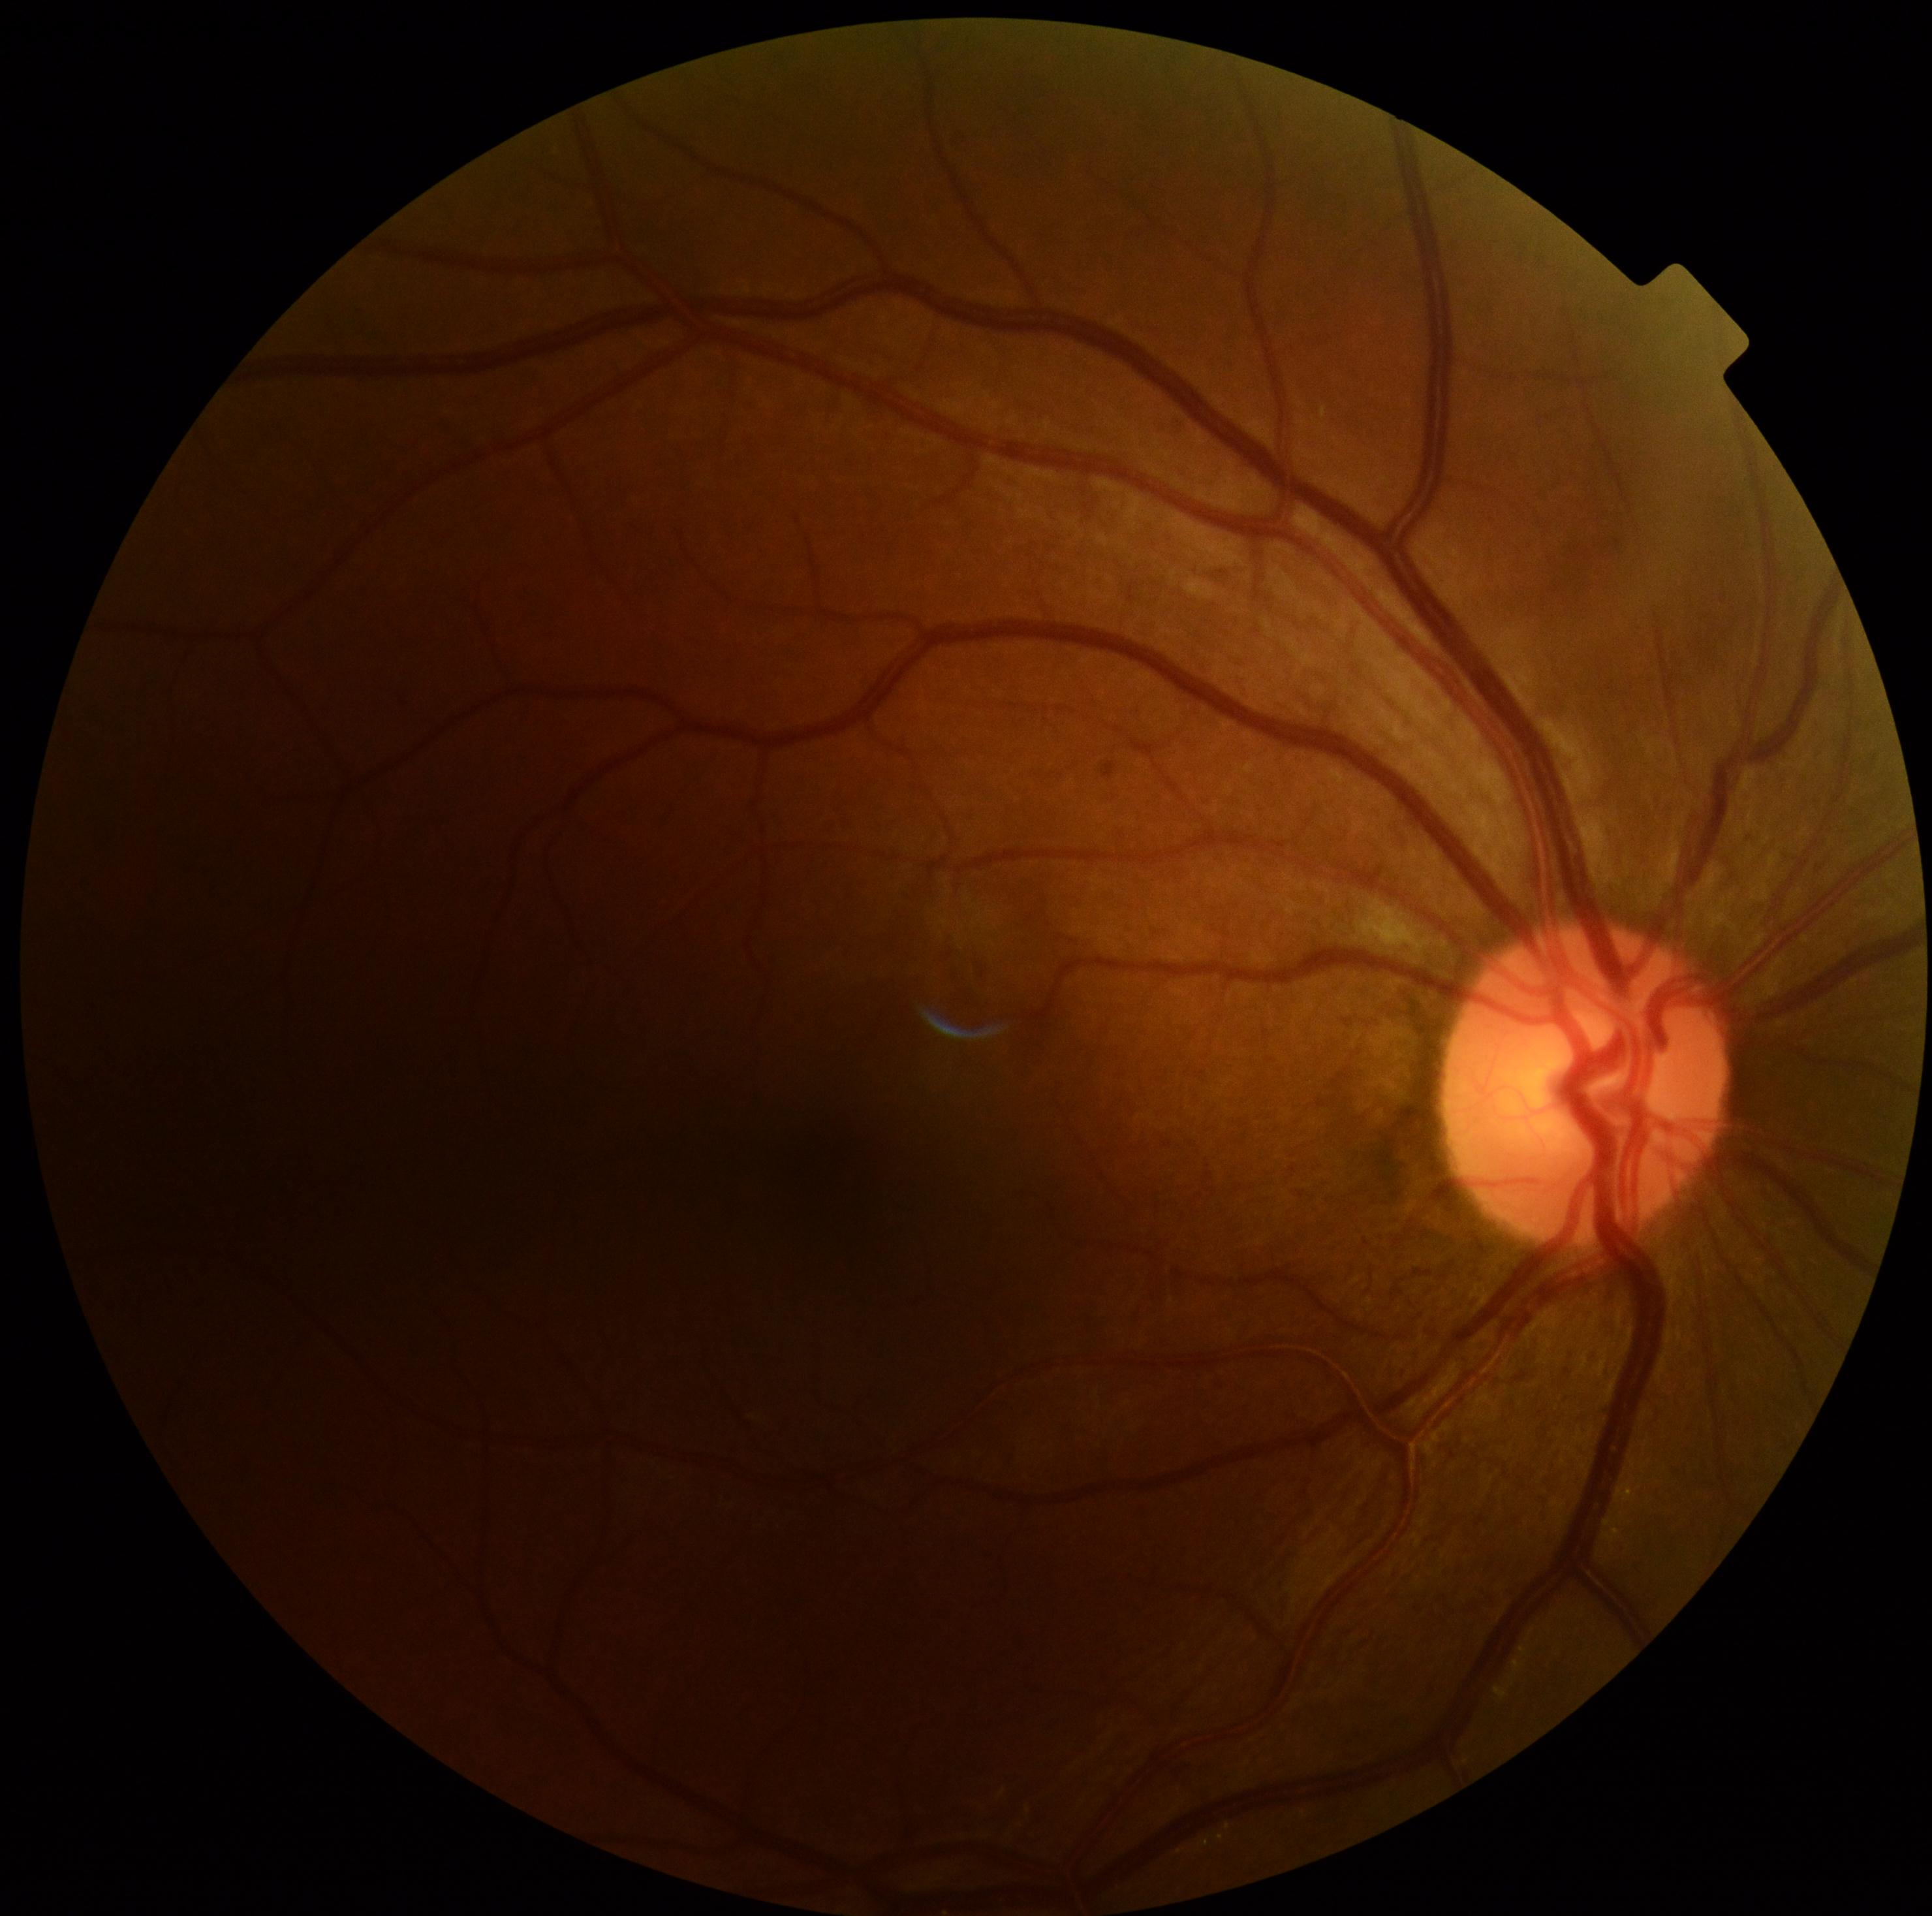 DR class: non-proliferative diabetic retinopathy. DR stage is grade 2.